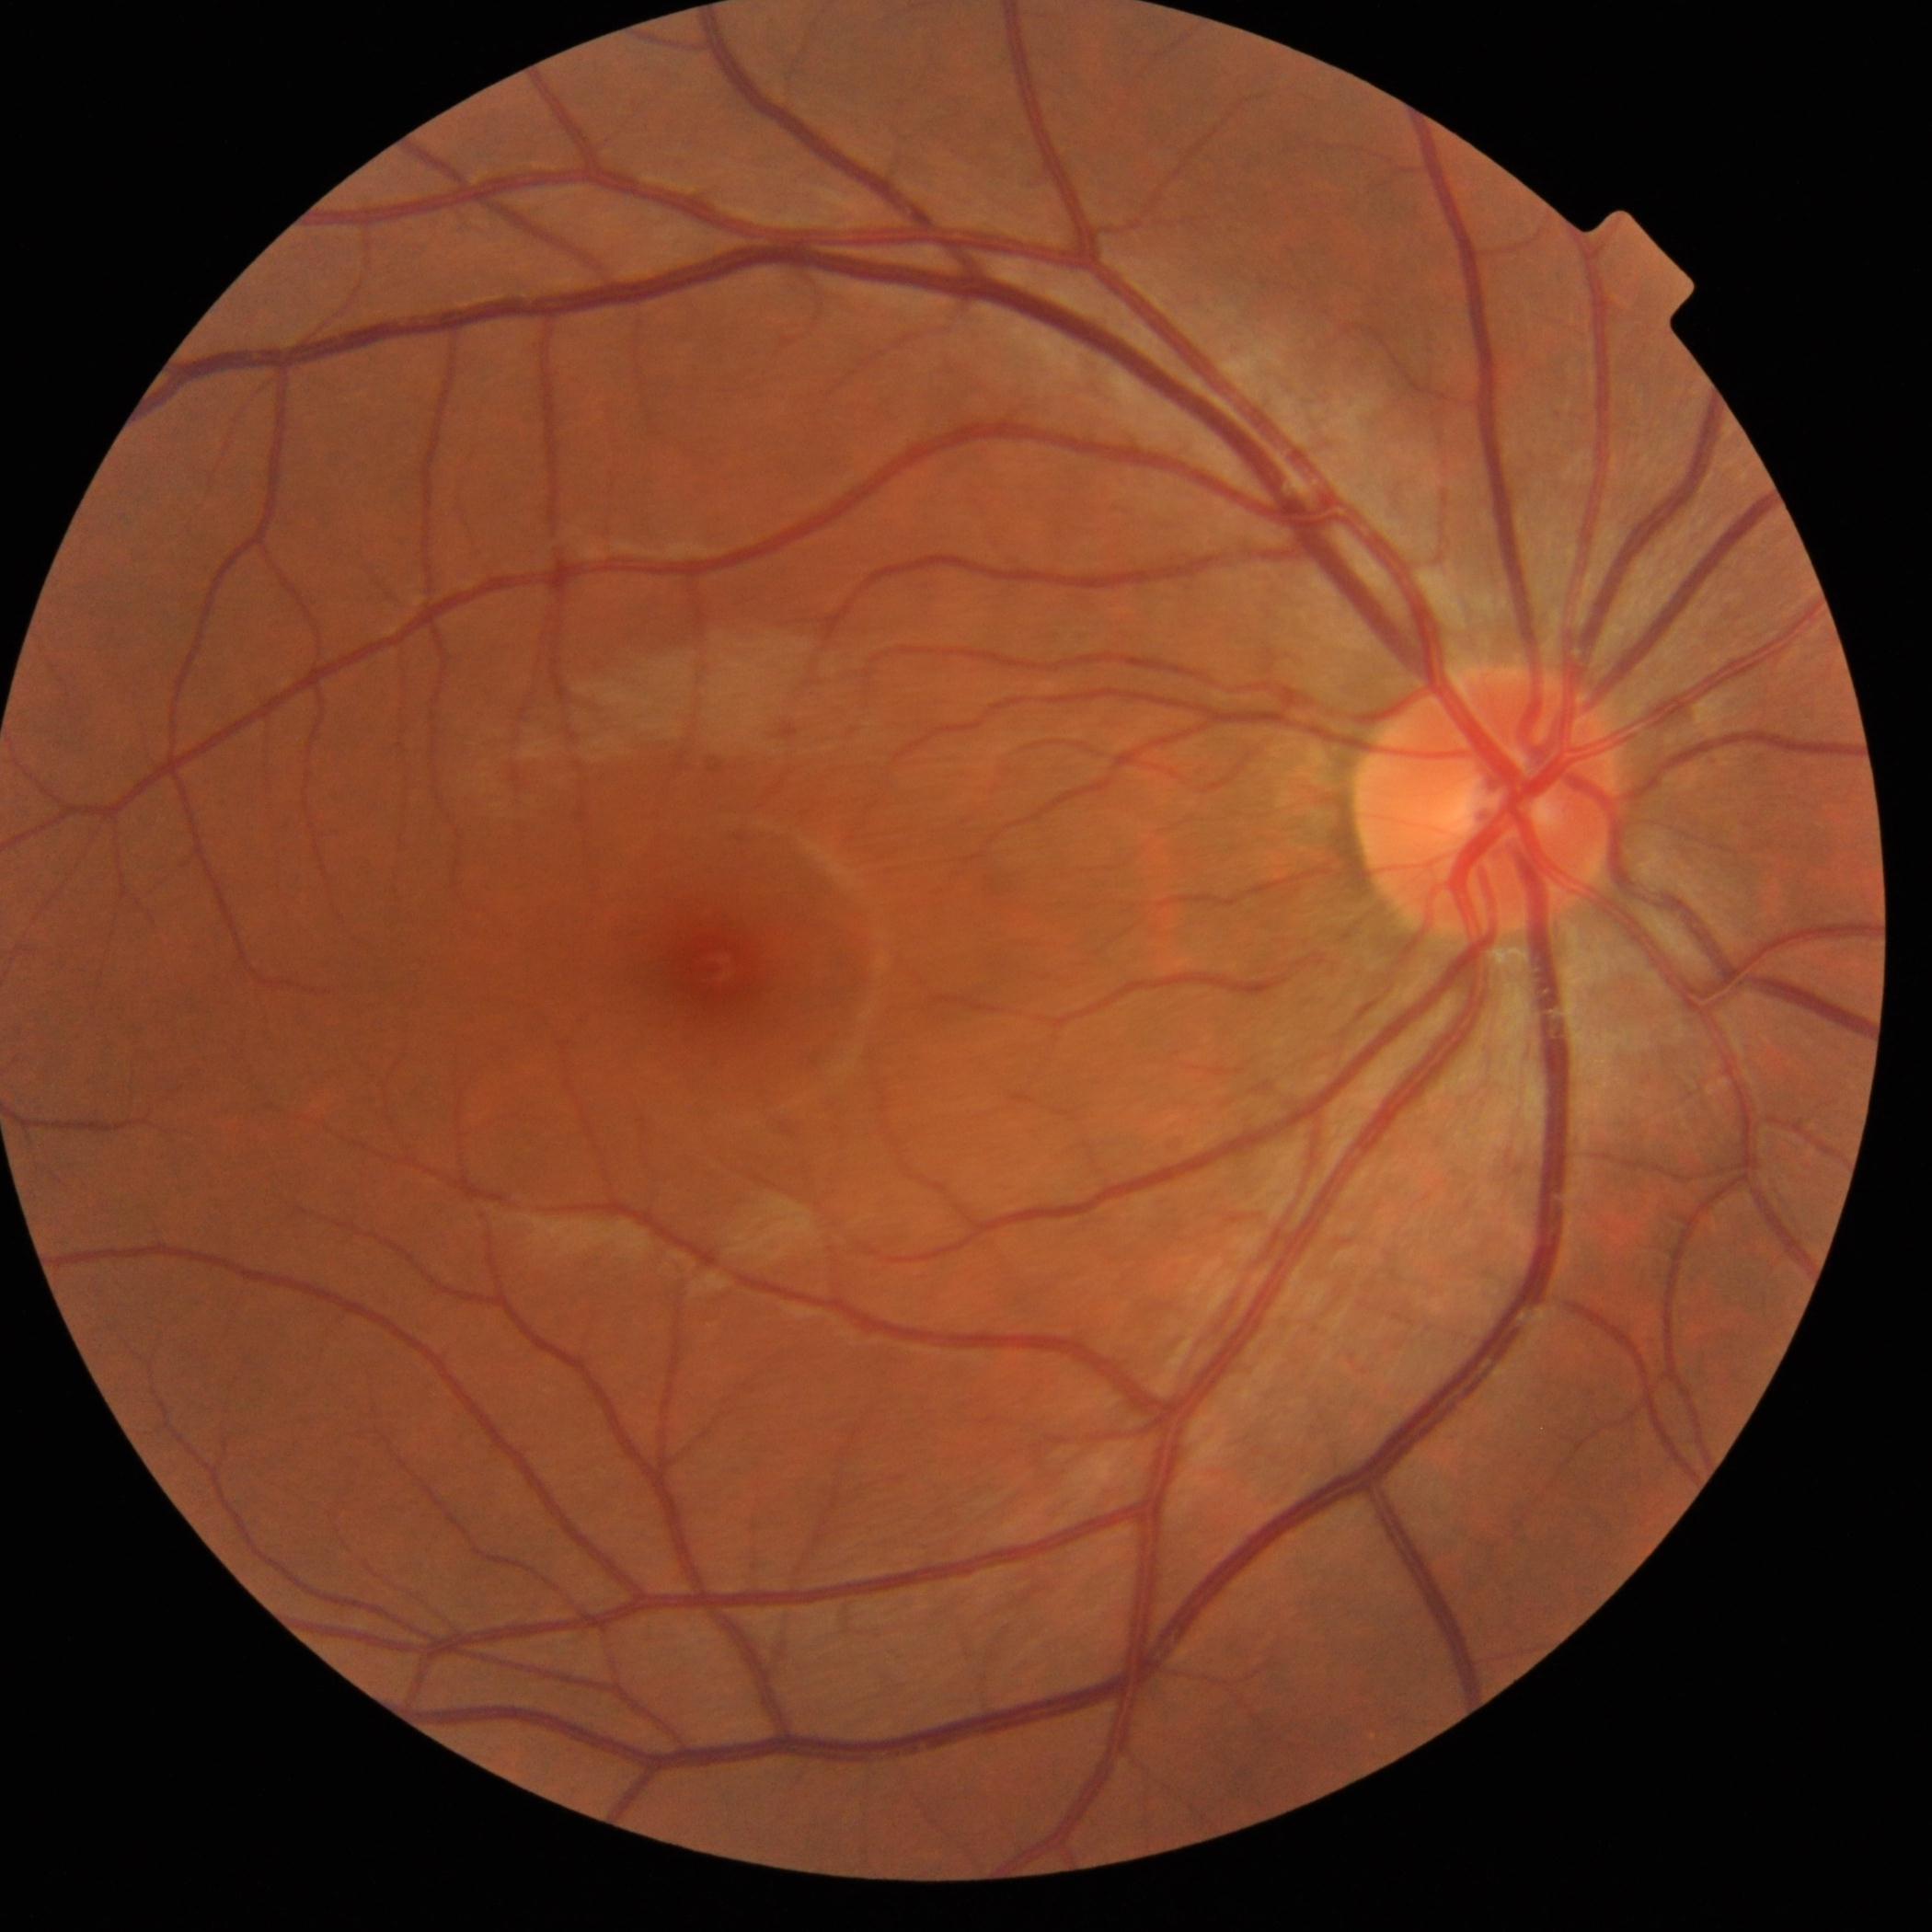
DR grade: no apparent retinopathy (0).